Posterior pole photograph
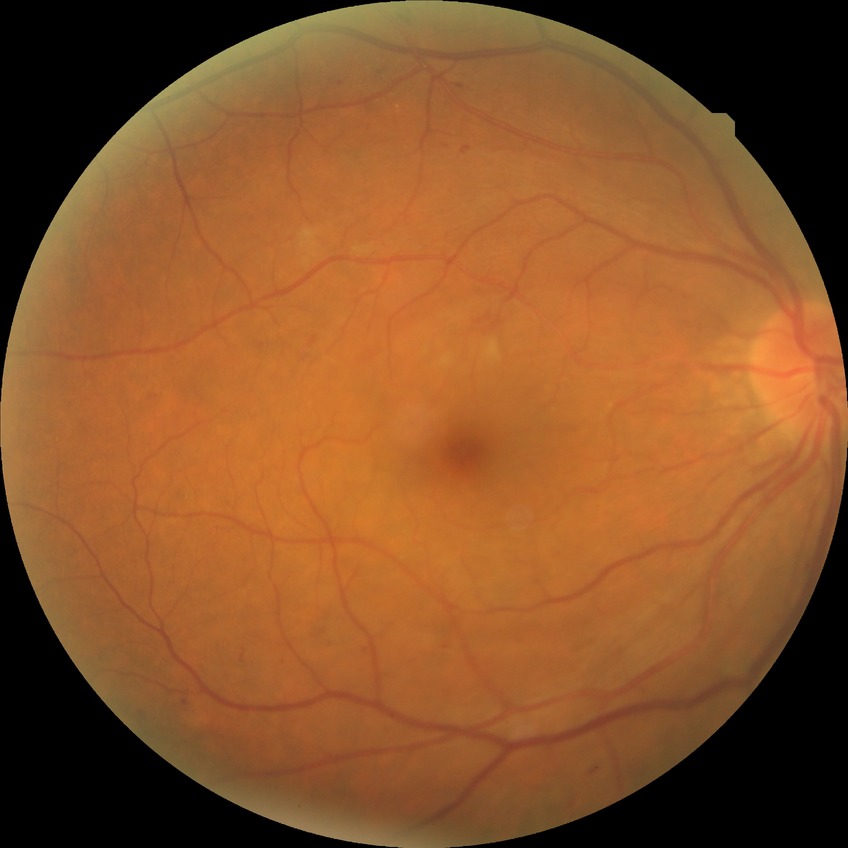

{"davis_grade": "SDR"}